45 degree fundus photograph. Retinal fundus photograph. No pharmacologic dilation.
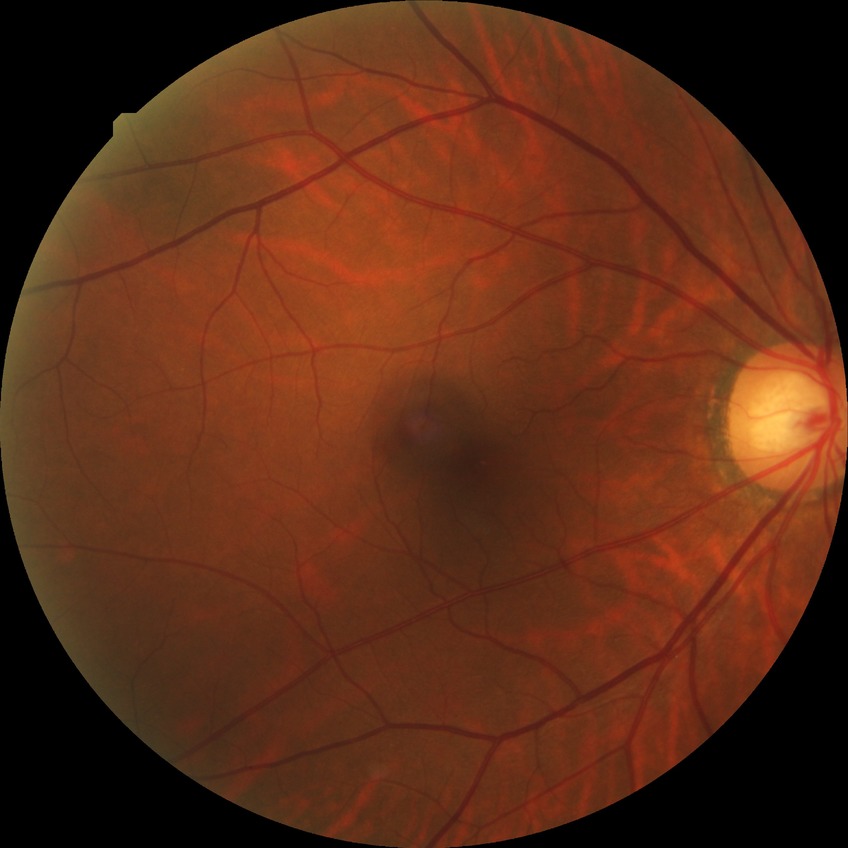 Diabetic retinopathy (DR) is no diabetic retinopathy (NDR).